848 by 848 pixels; nonmydriatic; fundus photo; NIDEK AFC-230: 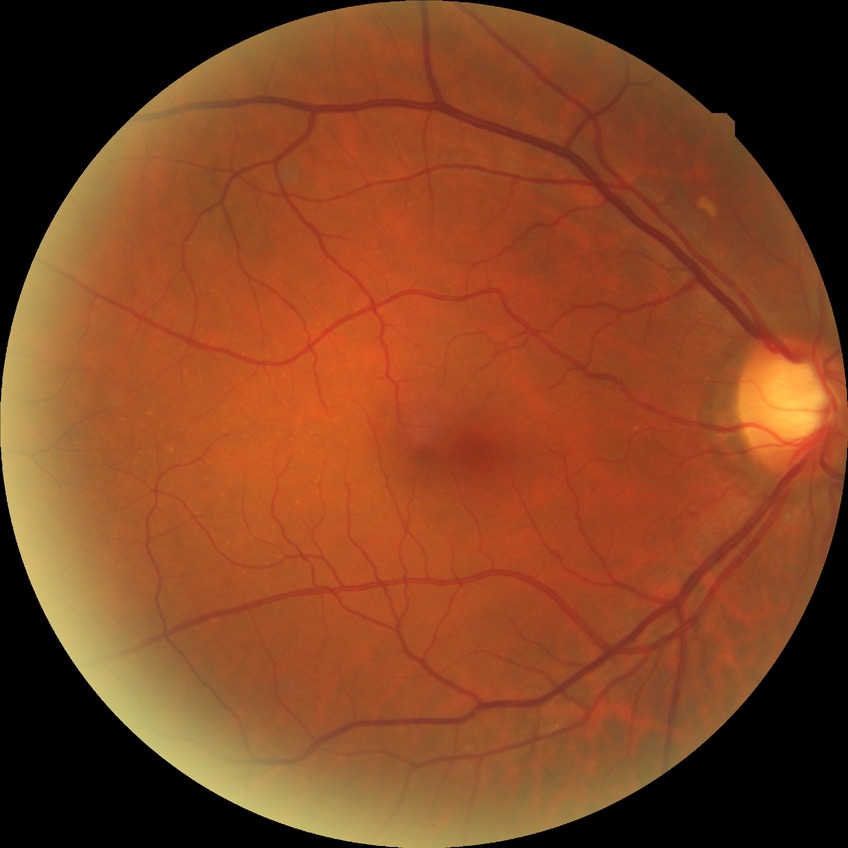

diabetic retinopathy (DR): no diabetic retinopathy (NDR).